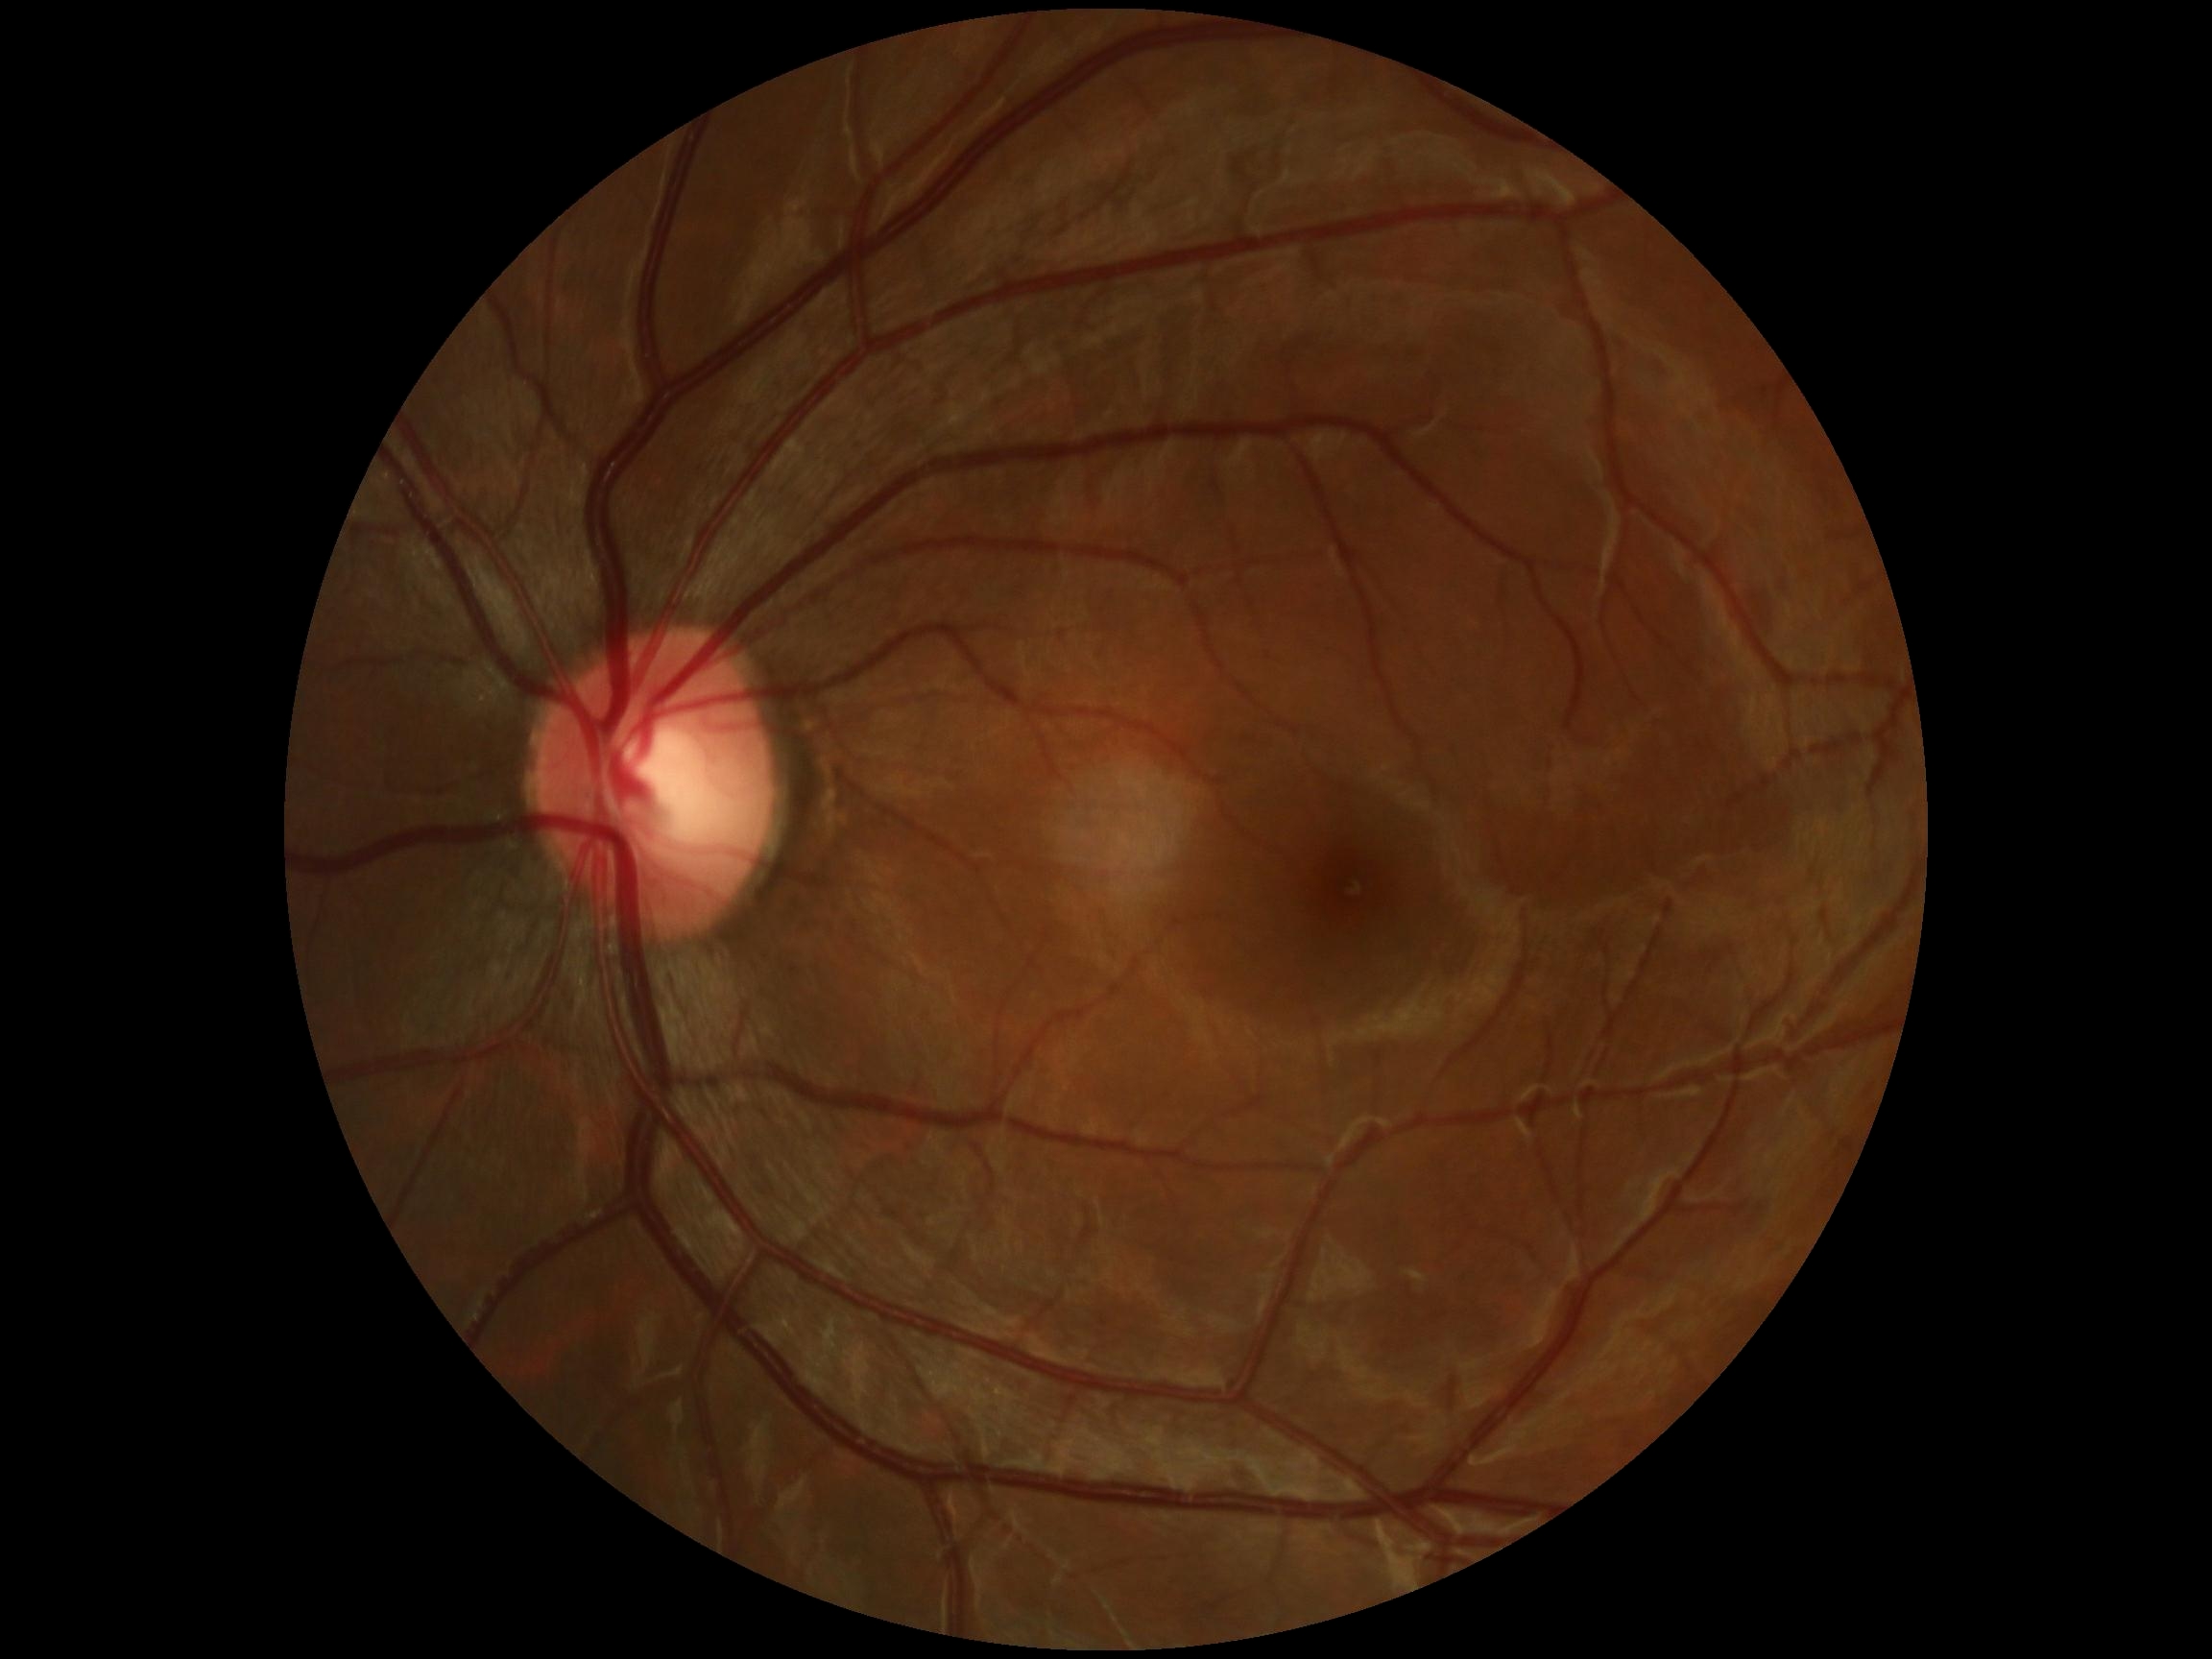 DR impression: no DR findings
diabetic retinopathy severity: 0